Pediatric retinal photograph (wide-field):
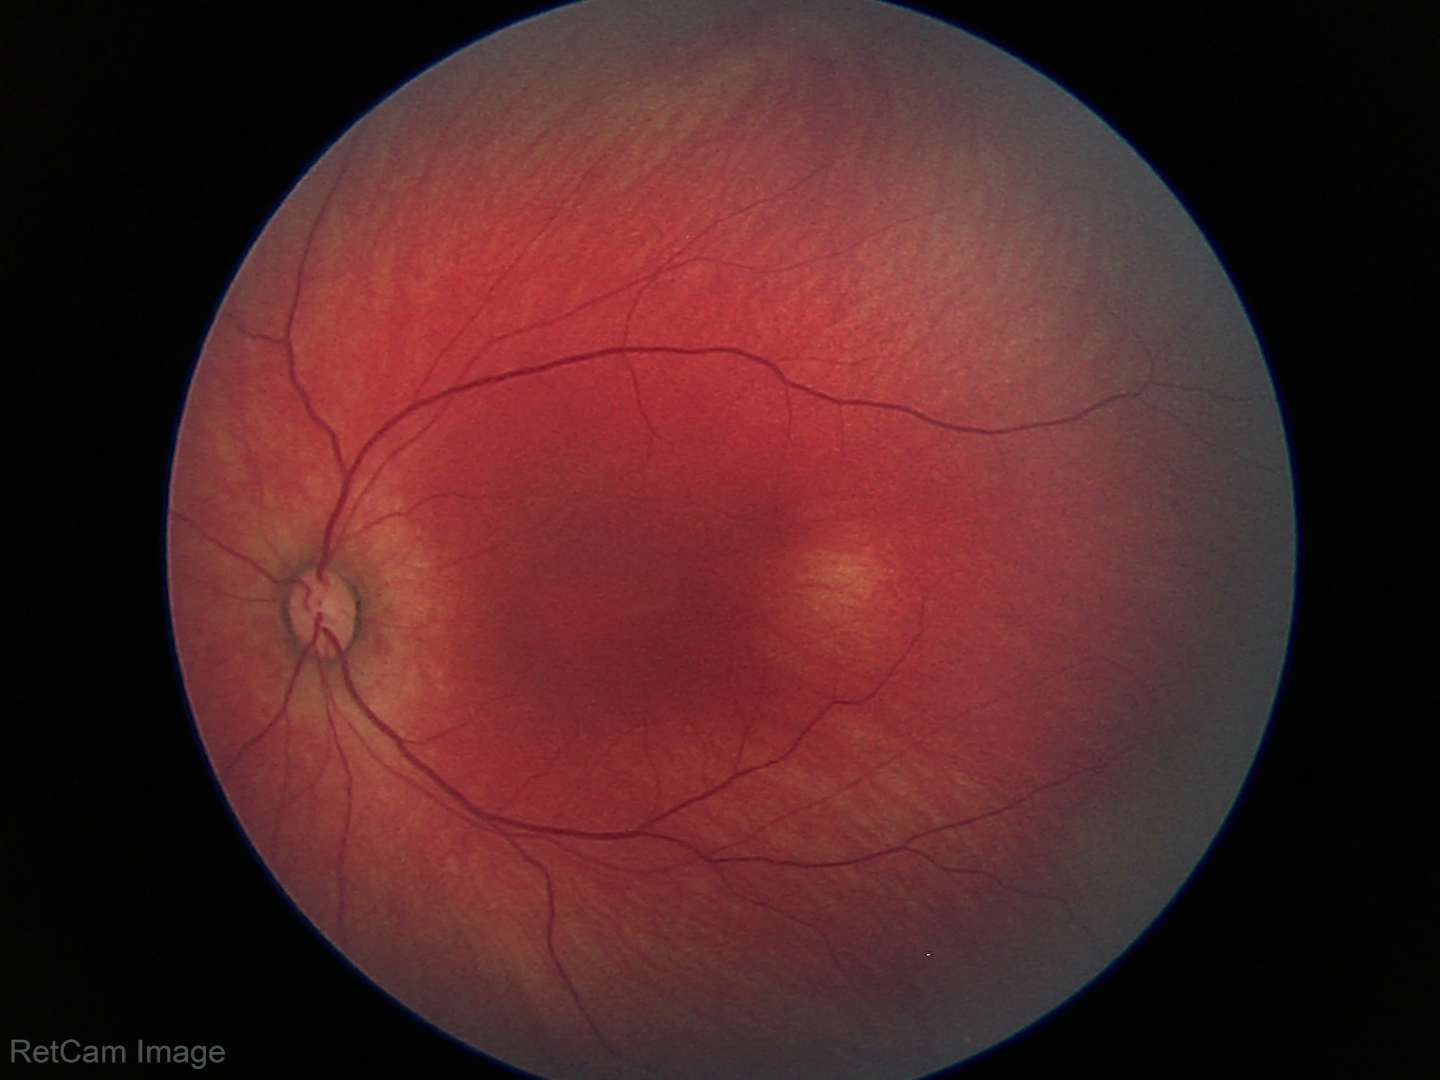

Physiological retinal appearance for postconceptual age.